Fundus photo.
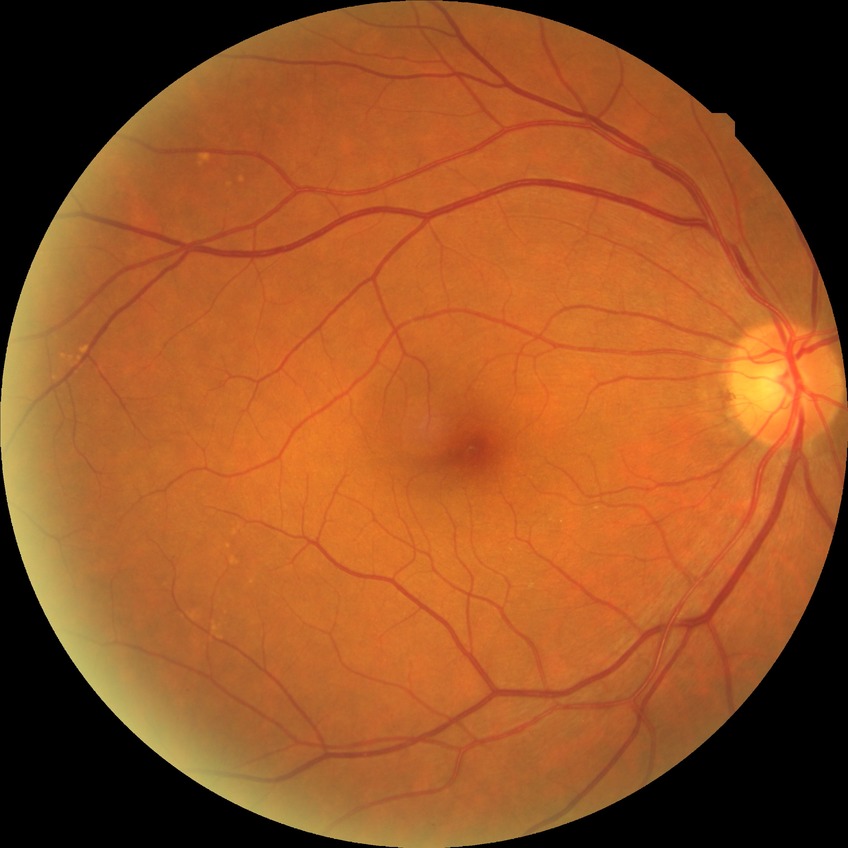

Diabetic retinopathy (DR): NDR (no diabetic retinopathy).